Captured with the Clarity RetCam 3 (130° field of view); pediatric retinal photograph (wide-field); 640 by 480 pixels.
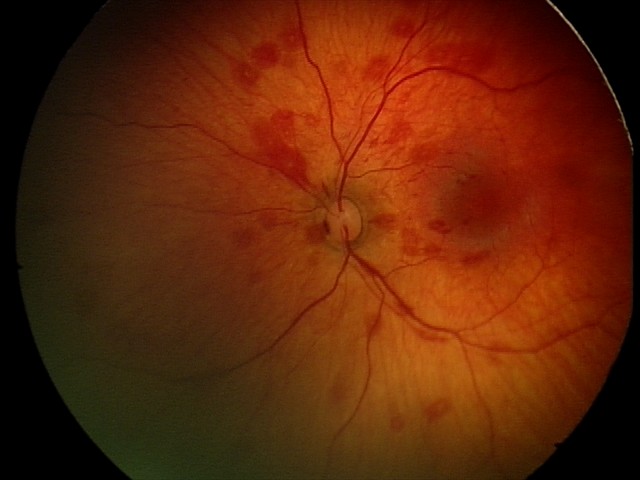 From an examination with diagnosis of retinal hemorrhages.